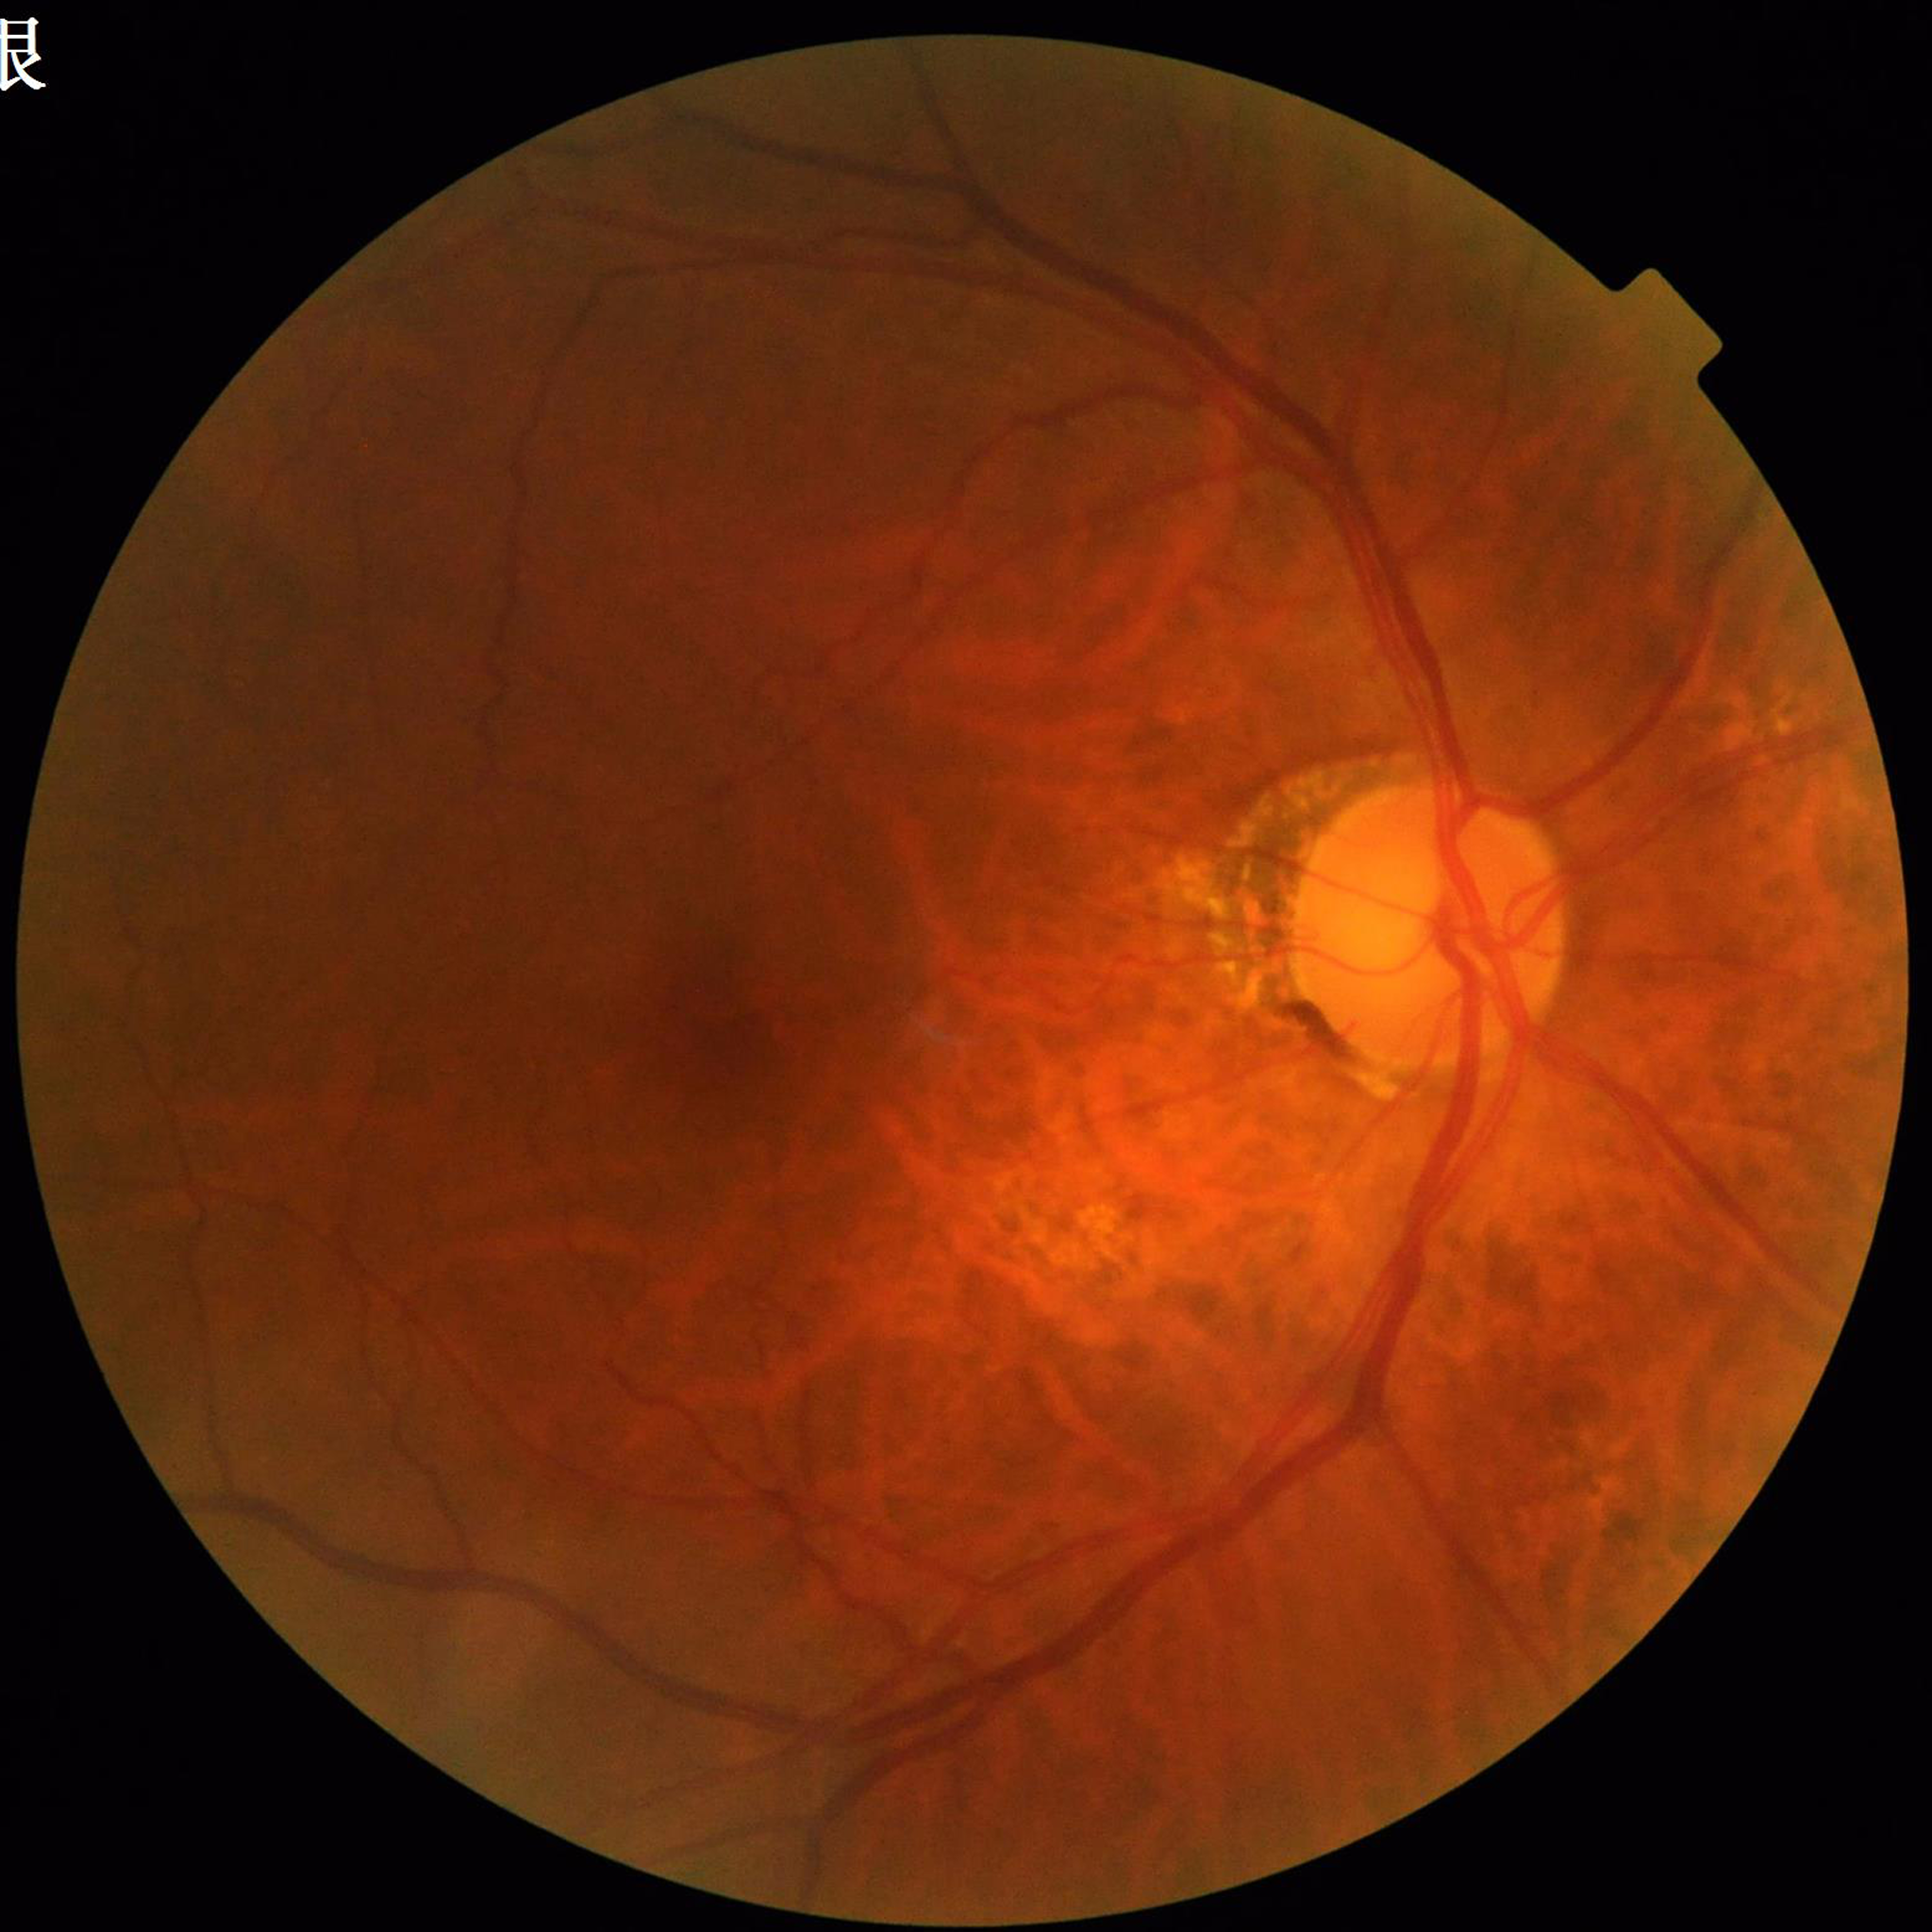
This fundus photograph is from a patient diagnosed with diabetic retinopathy (DR). Quality assessment: no blur, illumination and color satisfactory, contrast adequate.